Clarity RetCam 3, 130° FOV. Pediatric wide-field fundus photograph. 640 by 480 pixels
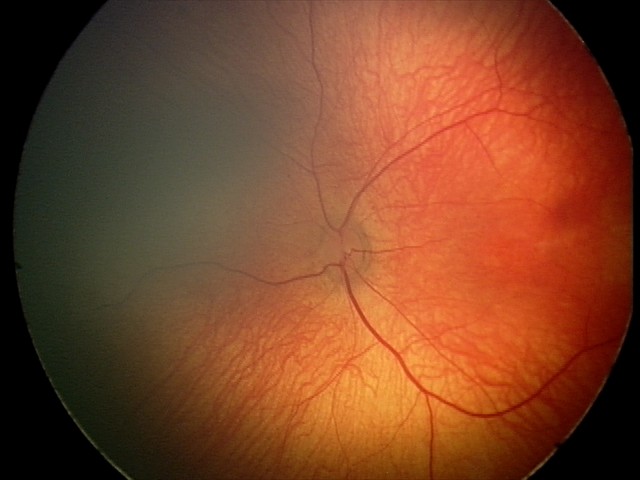 No retinal pathology identified on screening.